45° field of view: 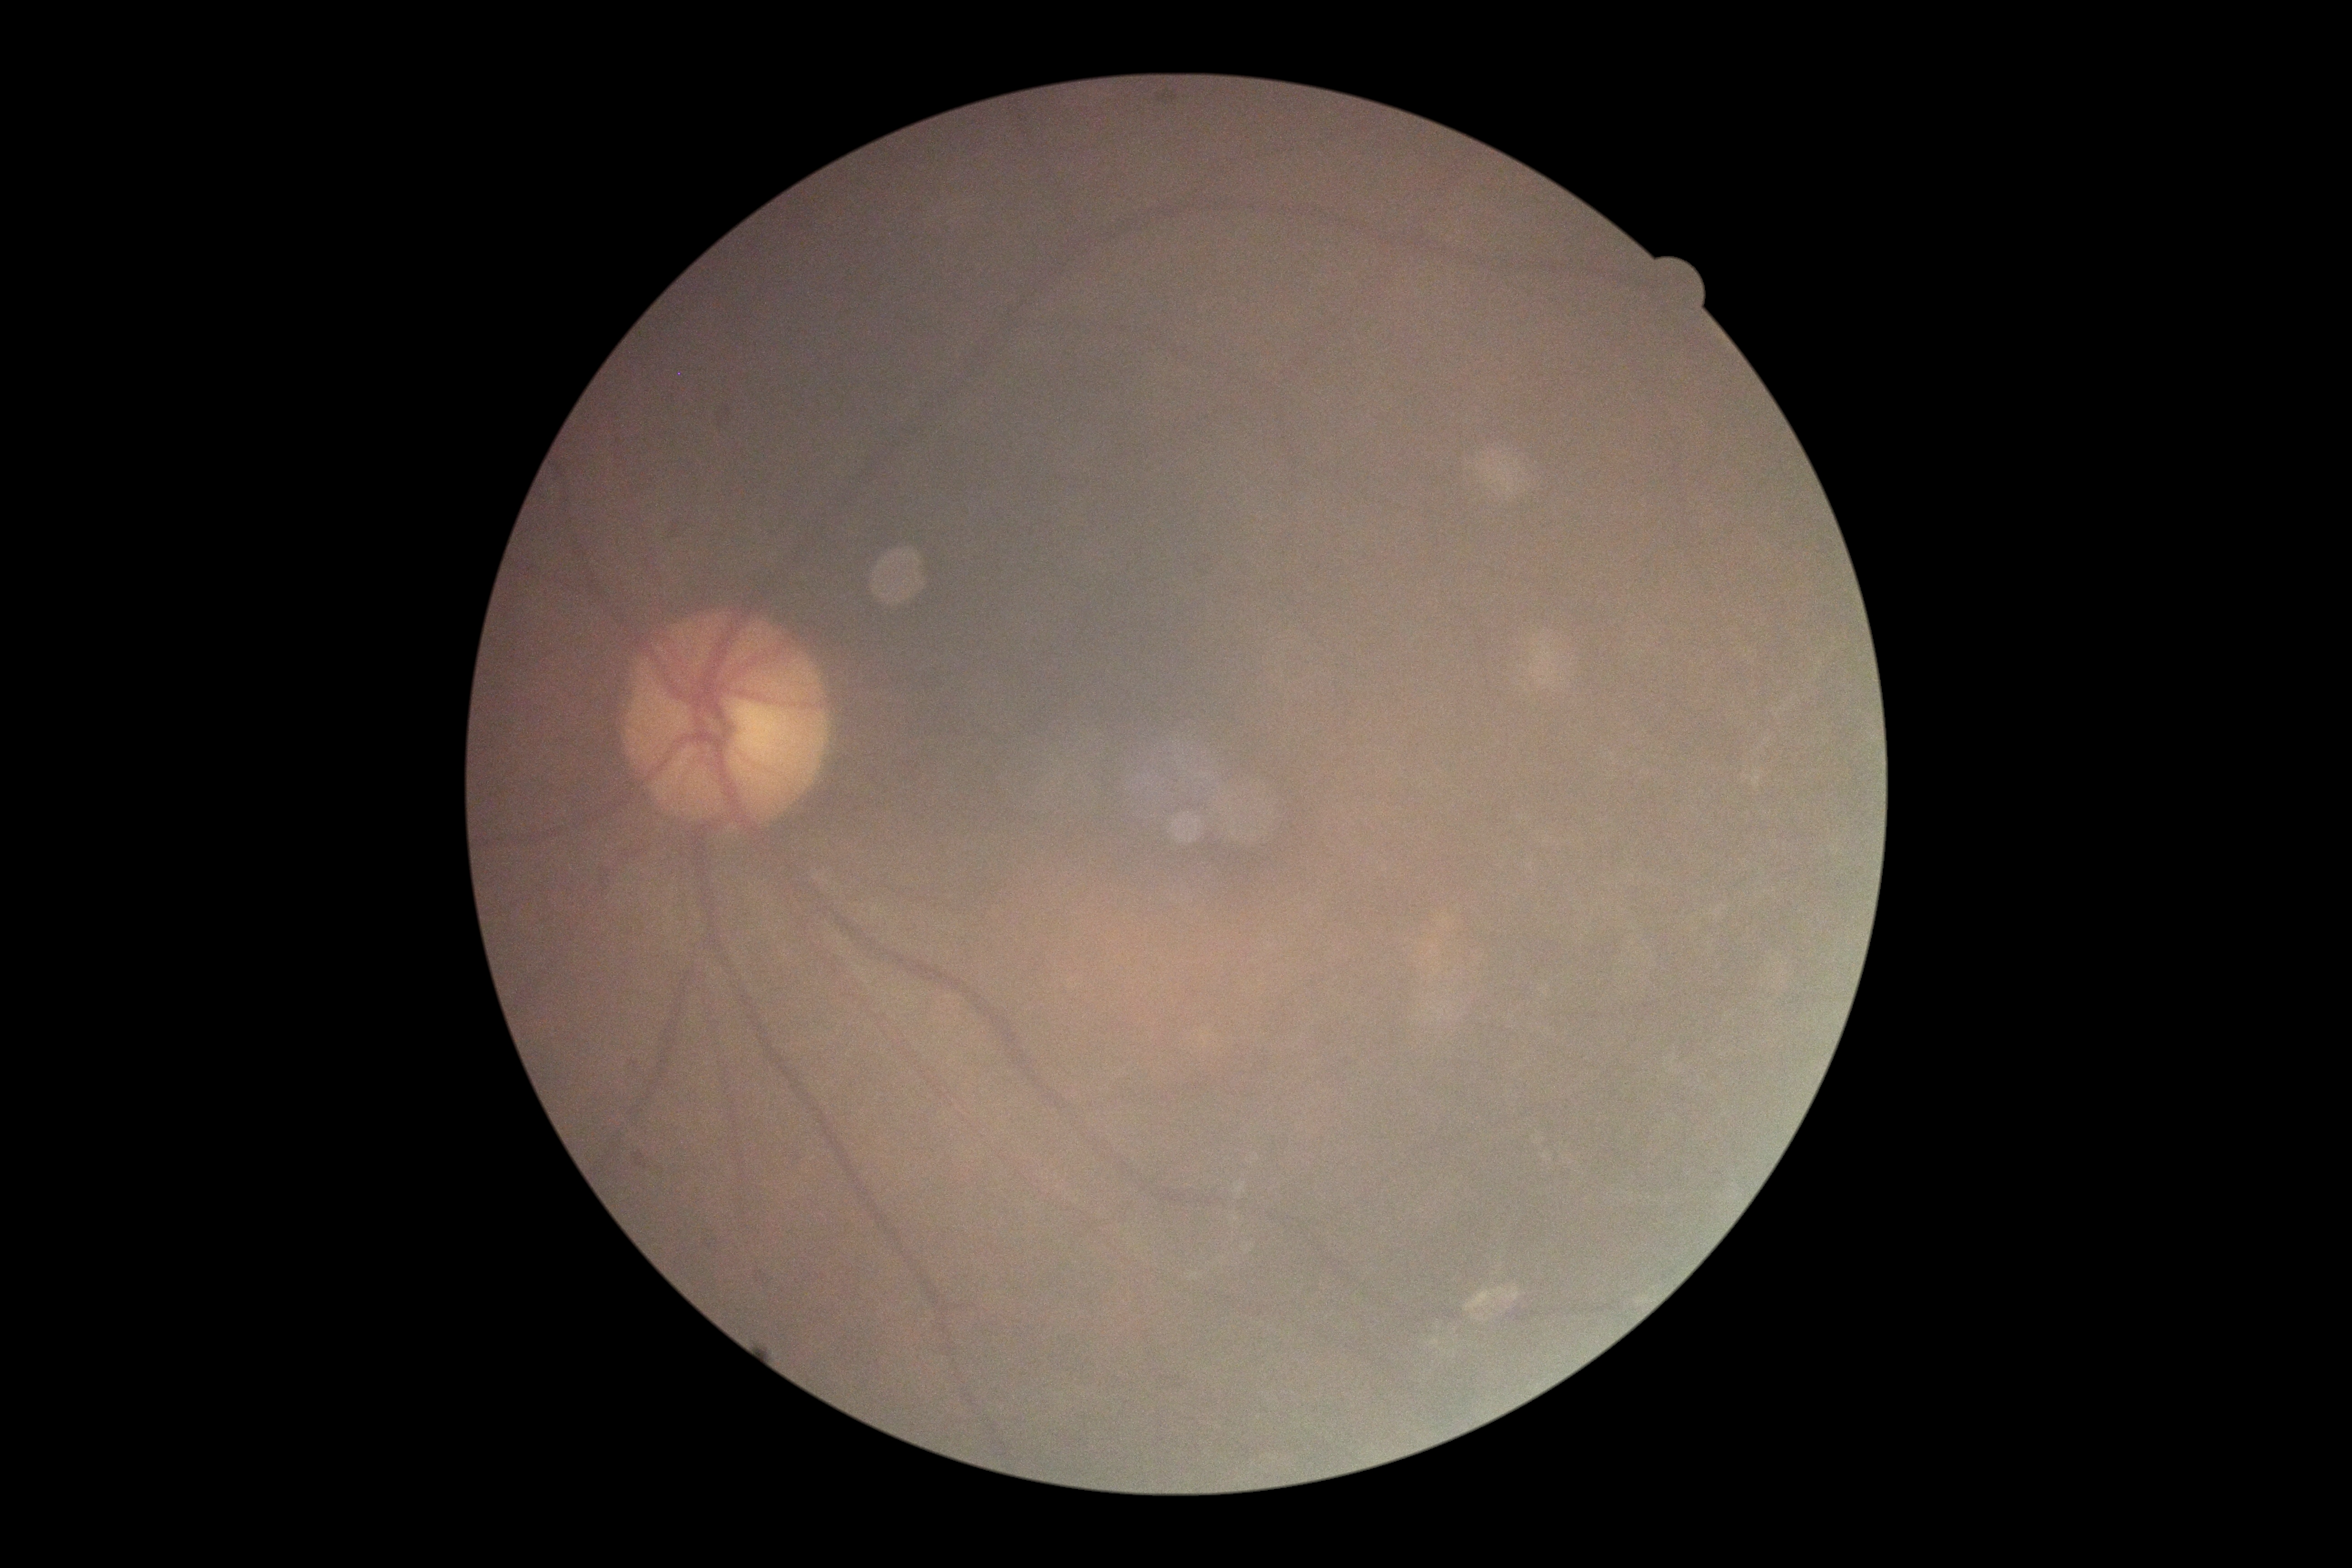 DR stage: grade 0.